DR severity per modified Davis staging.
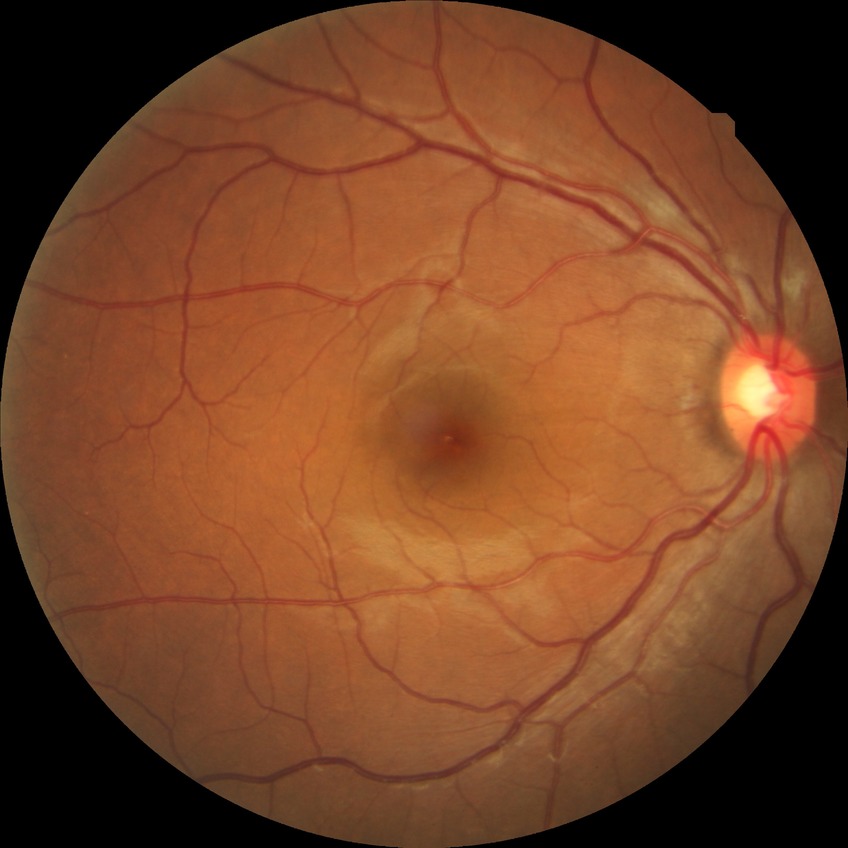
Diabetic retinopathy grade is no diabetic retinopathy.